FOV: 45 degrees, 848x848px, NIDEK AFC-230, without pupil dilation
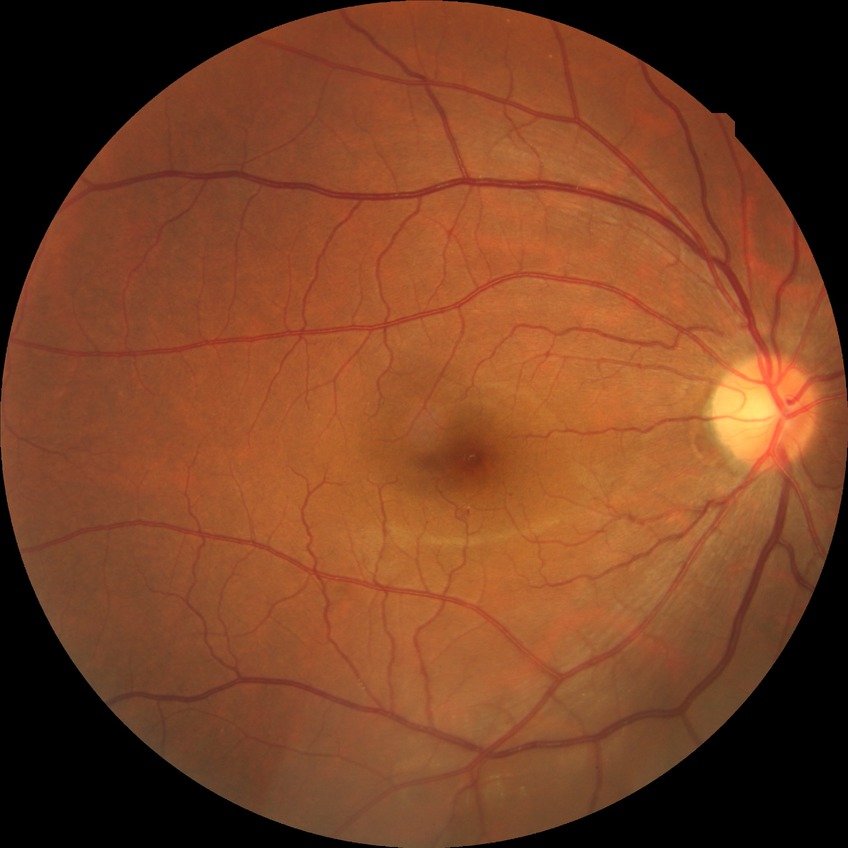
Retinopathy stage: no diabetic retinopathy.